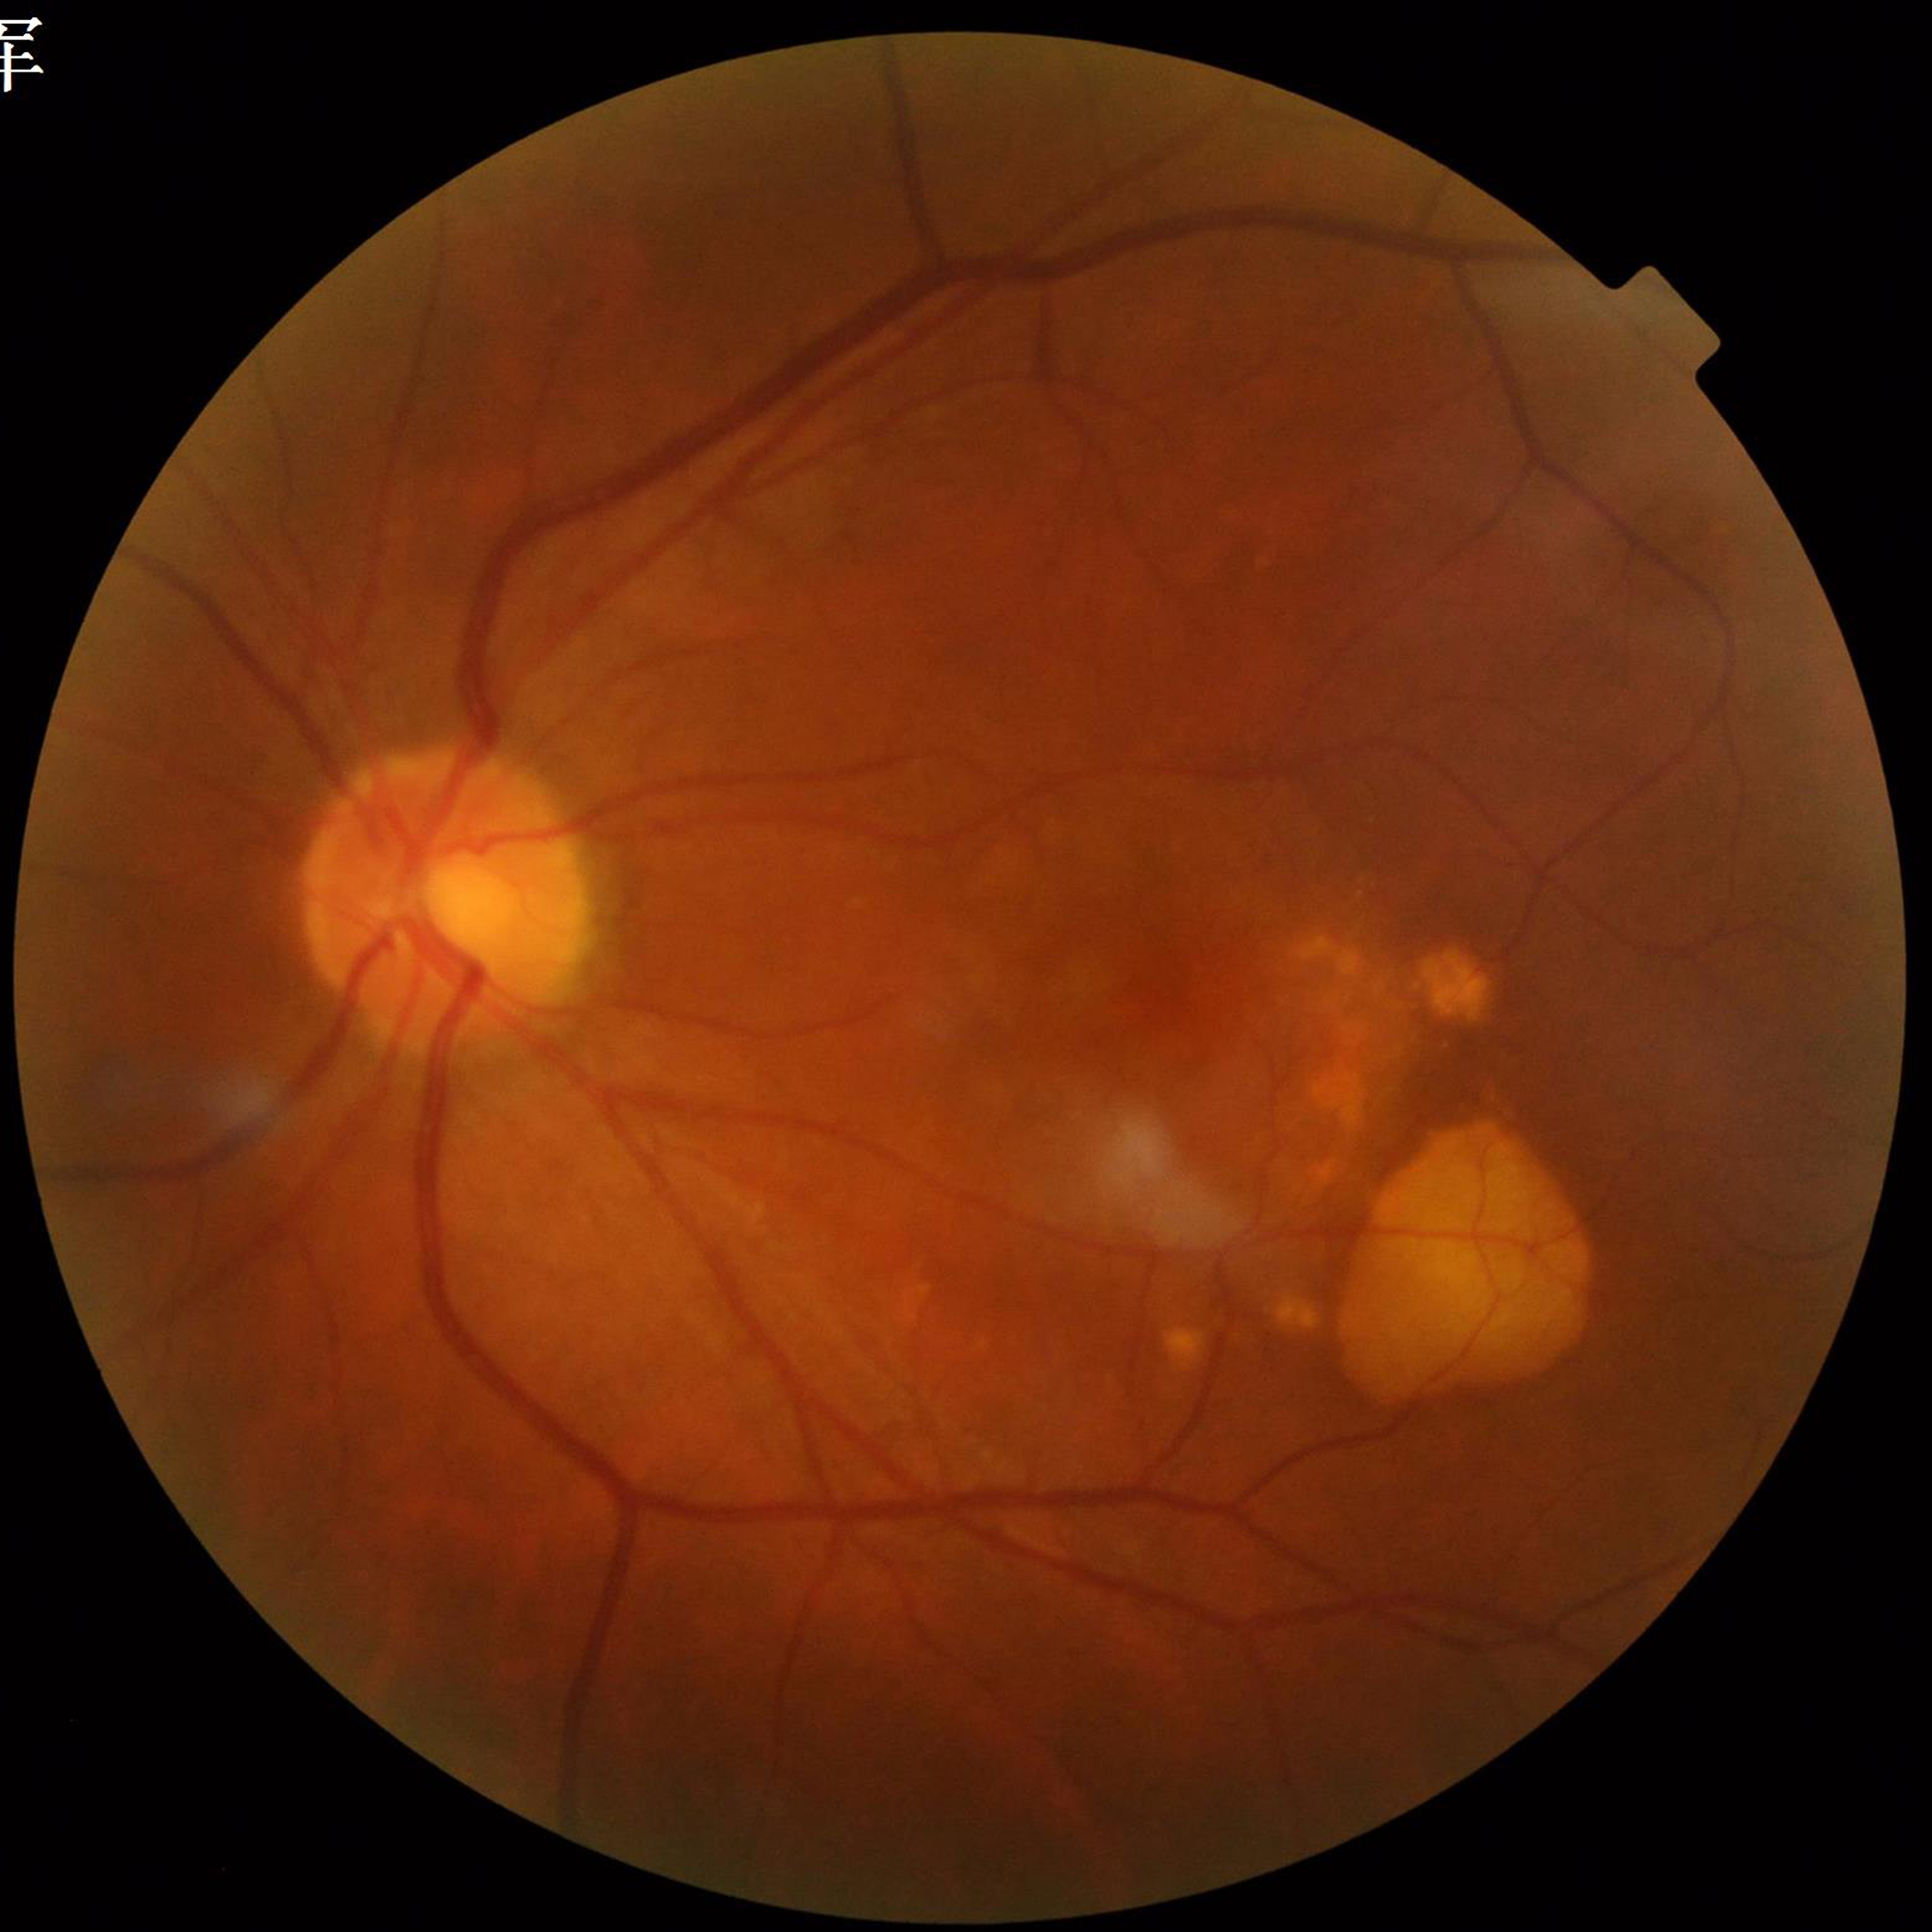 Disease class = age-related macular degeneration (AMD); Quality assessment = good.